Wide-field contact fundus photograph of an infant:
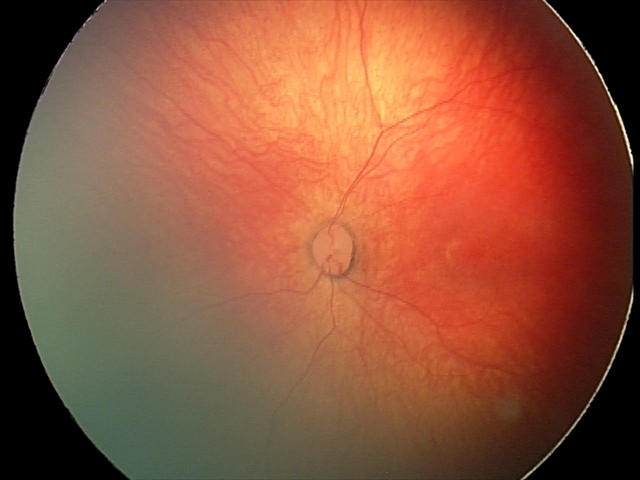

Screening diagnosis: normal fundus examination.